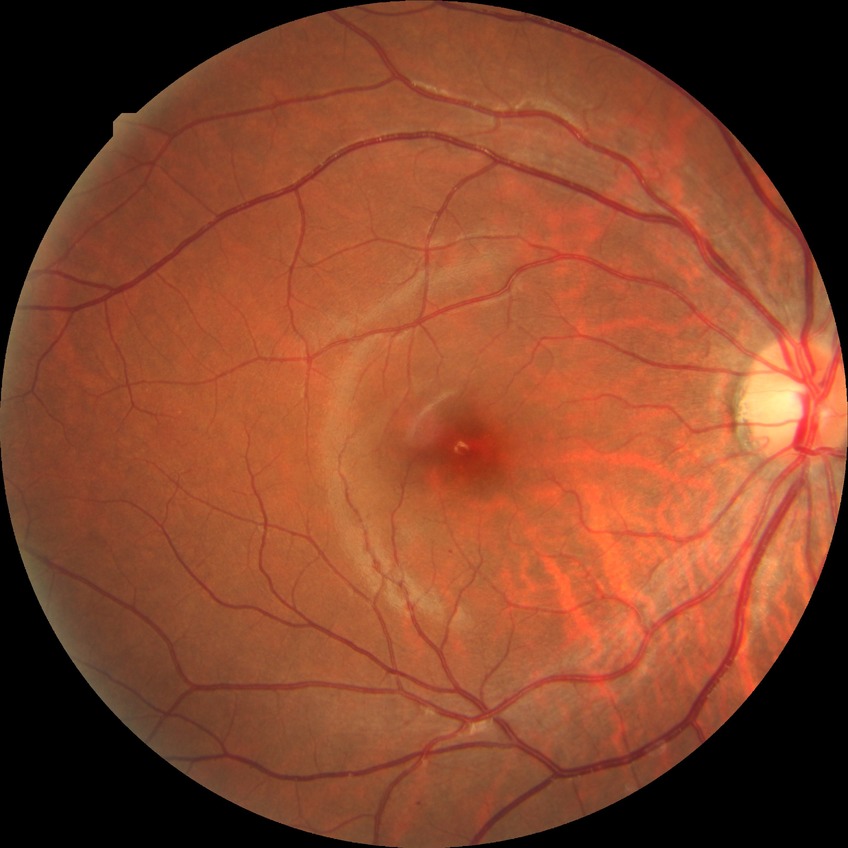 Diabetic retinopathy (DR): simple diabetic retinopathy (SDR).